DR severity per modified Davis staging, nonmydriatic
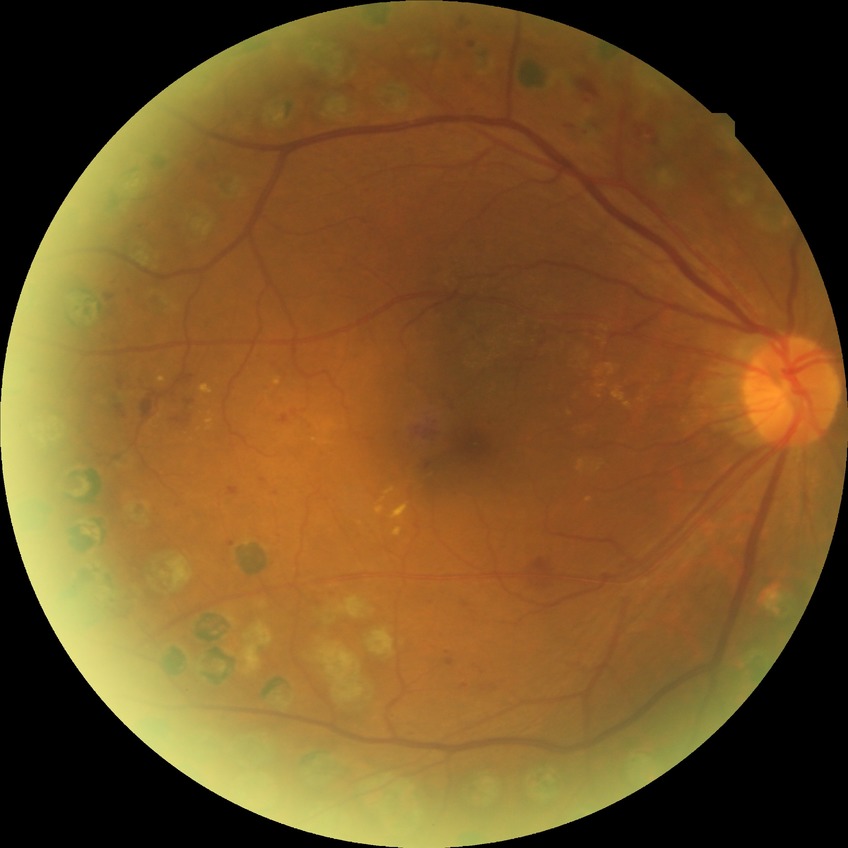 DR: PDR.